2048 x 1536 pixels.
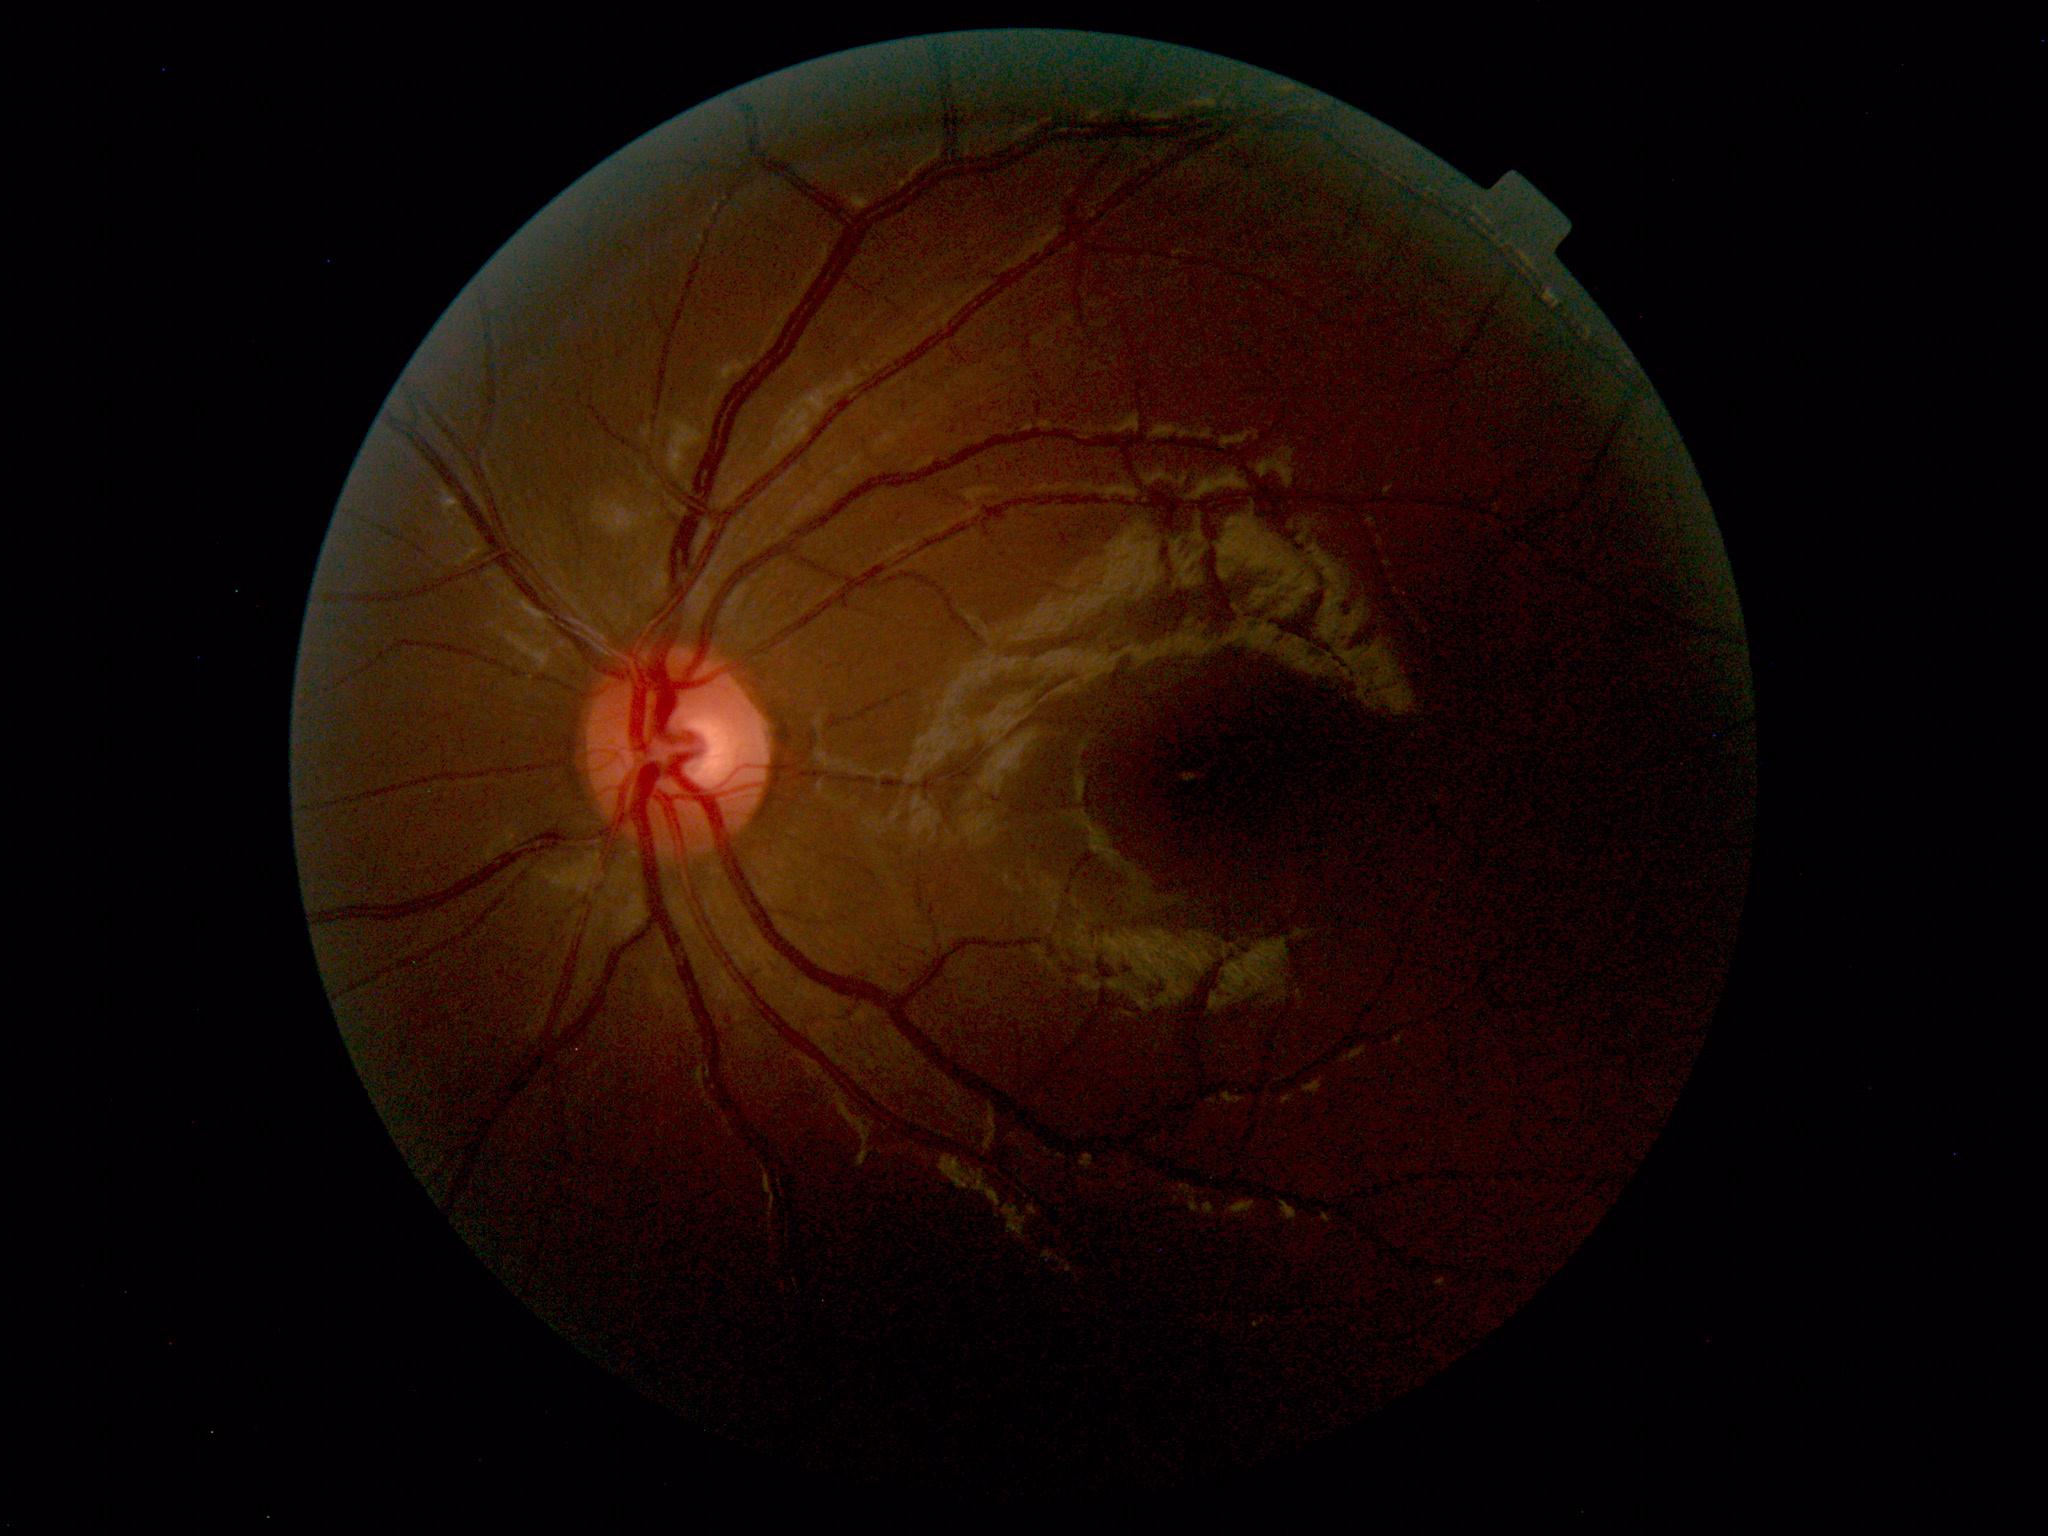
Within normal limits. No abnormalities identified.